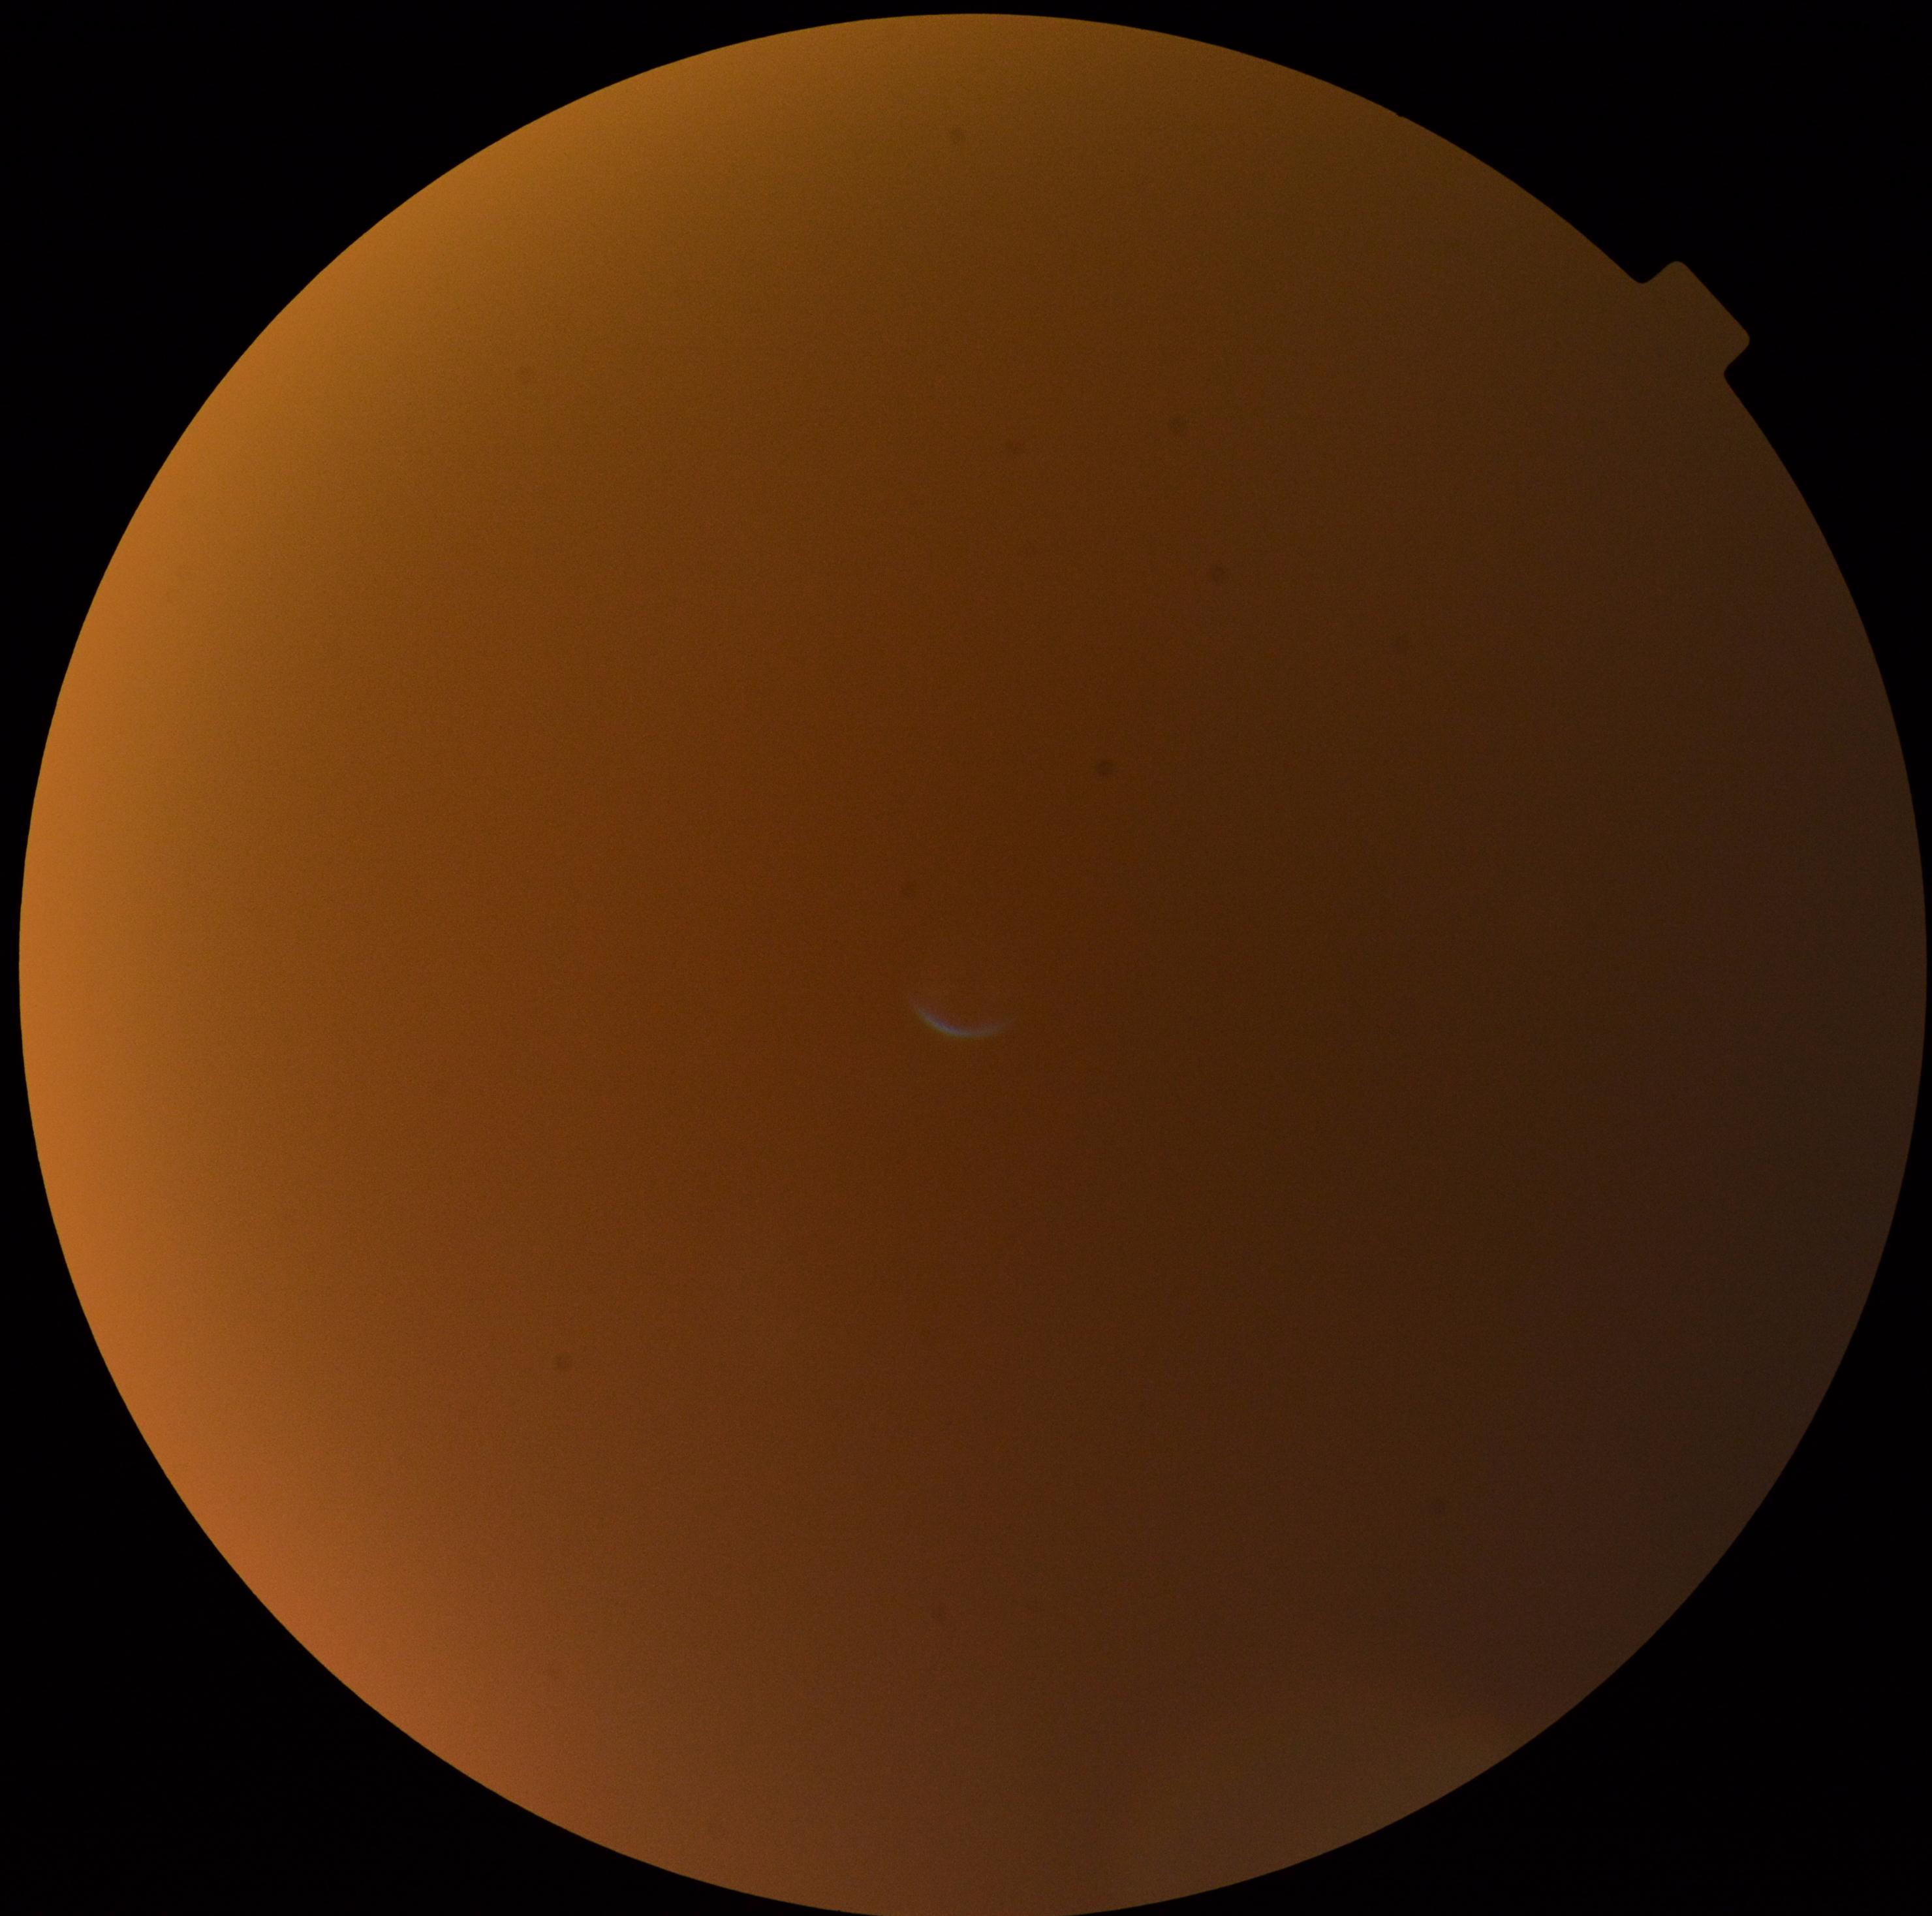

dr_grade: ungradable due to poor image quality